Wide-field fundus photograph of an infant: 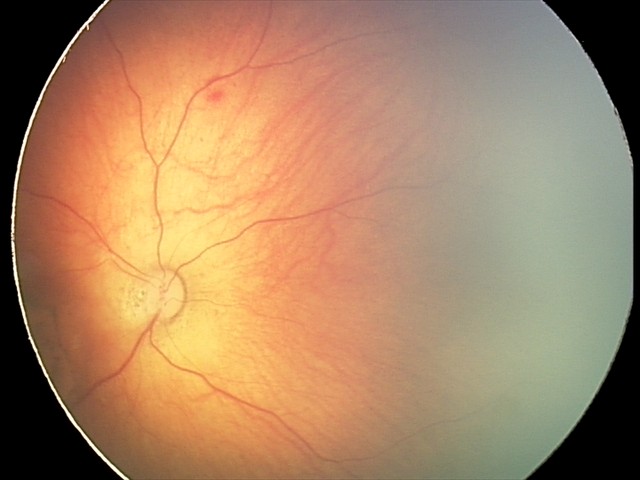

Screening diagnosis: toxoplasmosis chorioretinitis.